Color fundus photograph: 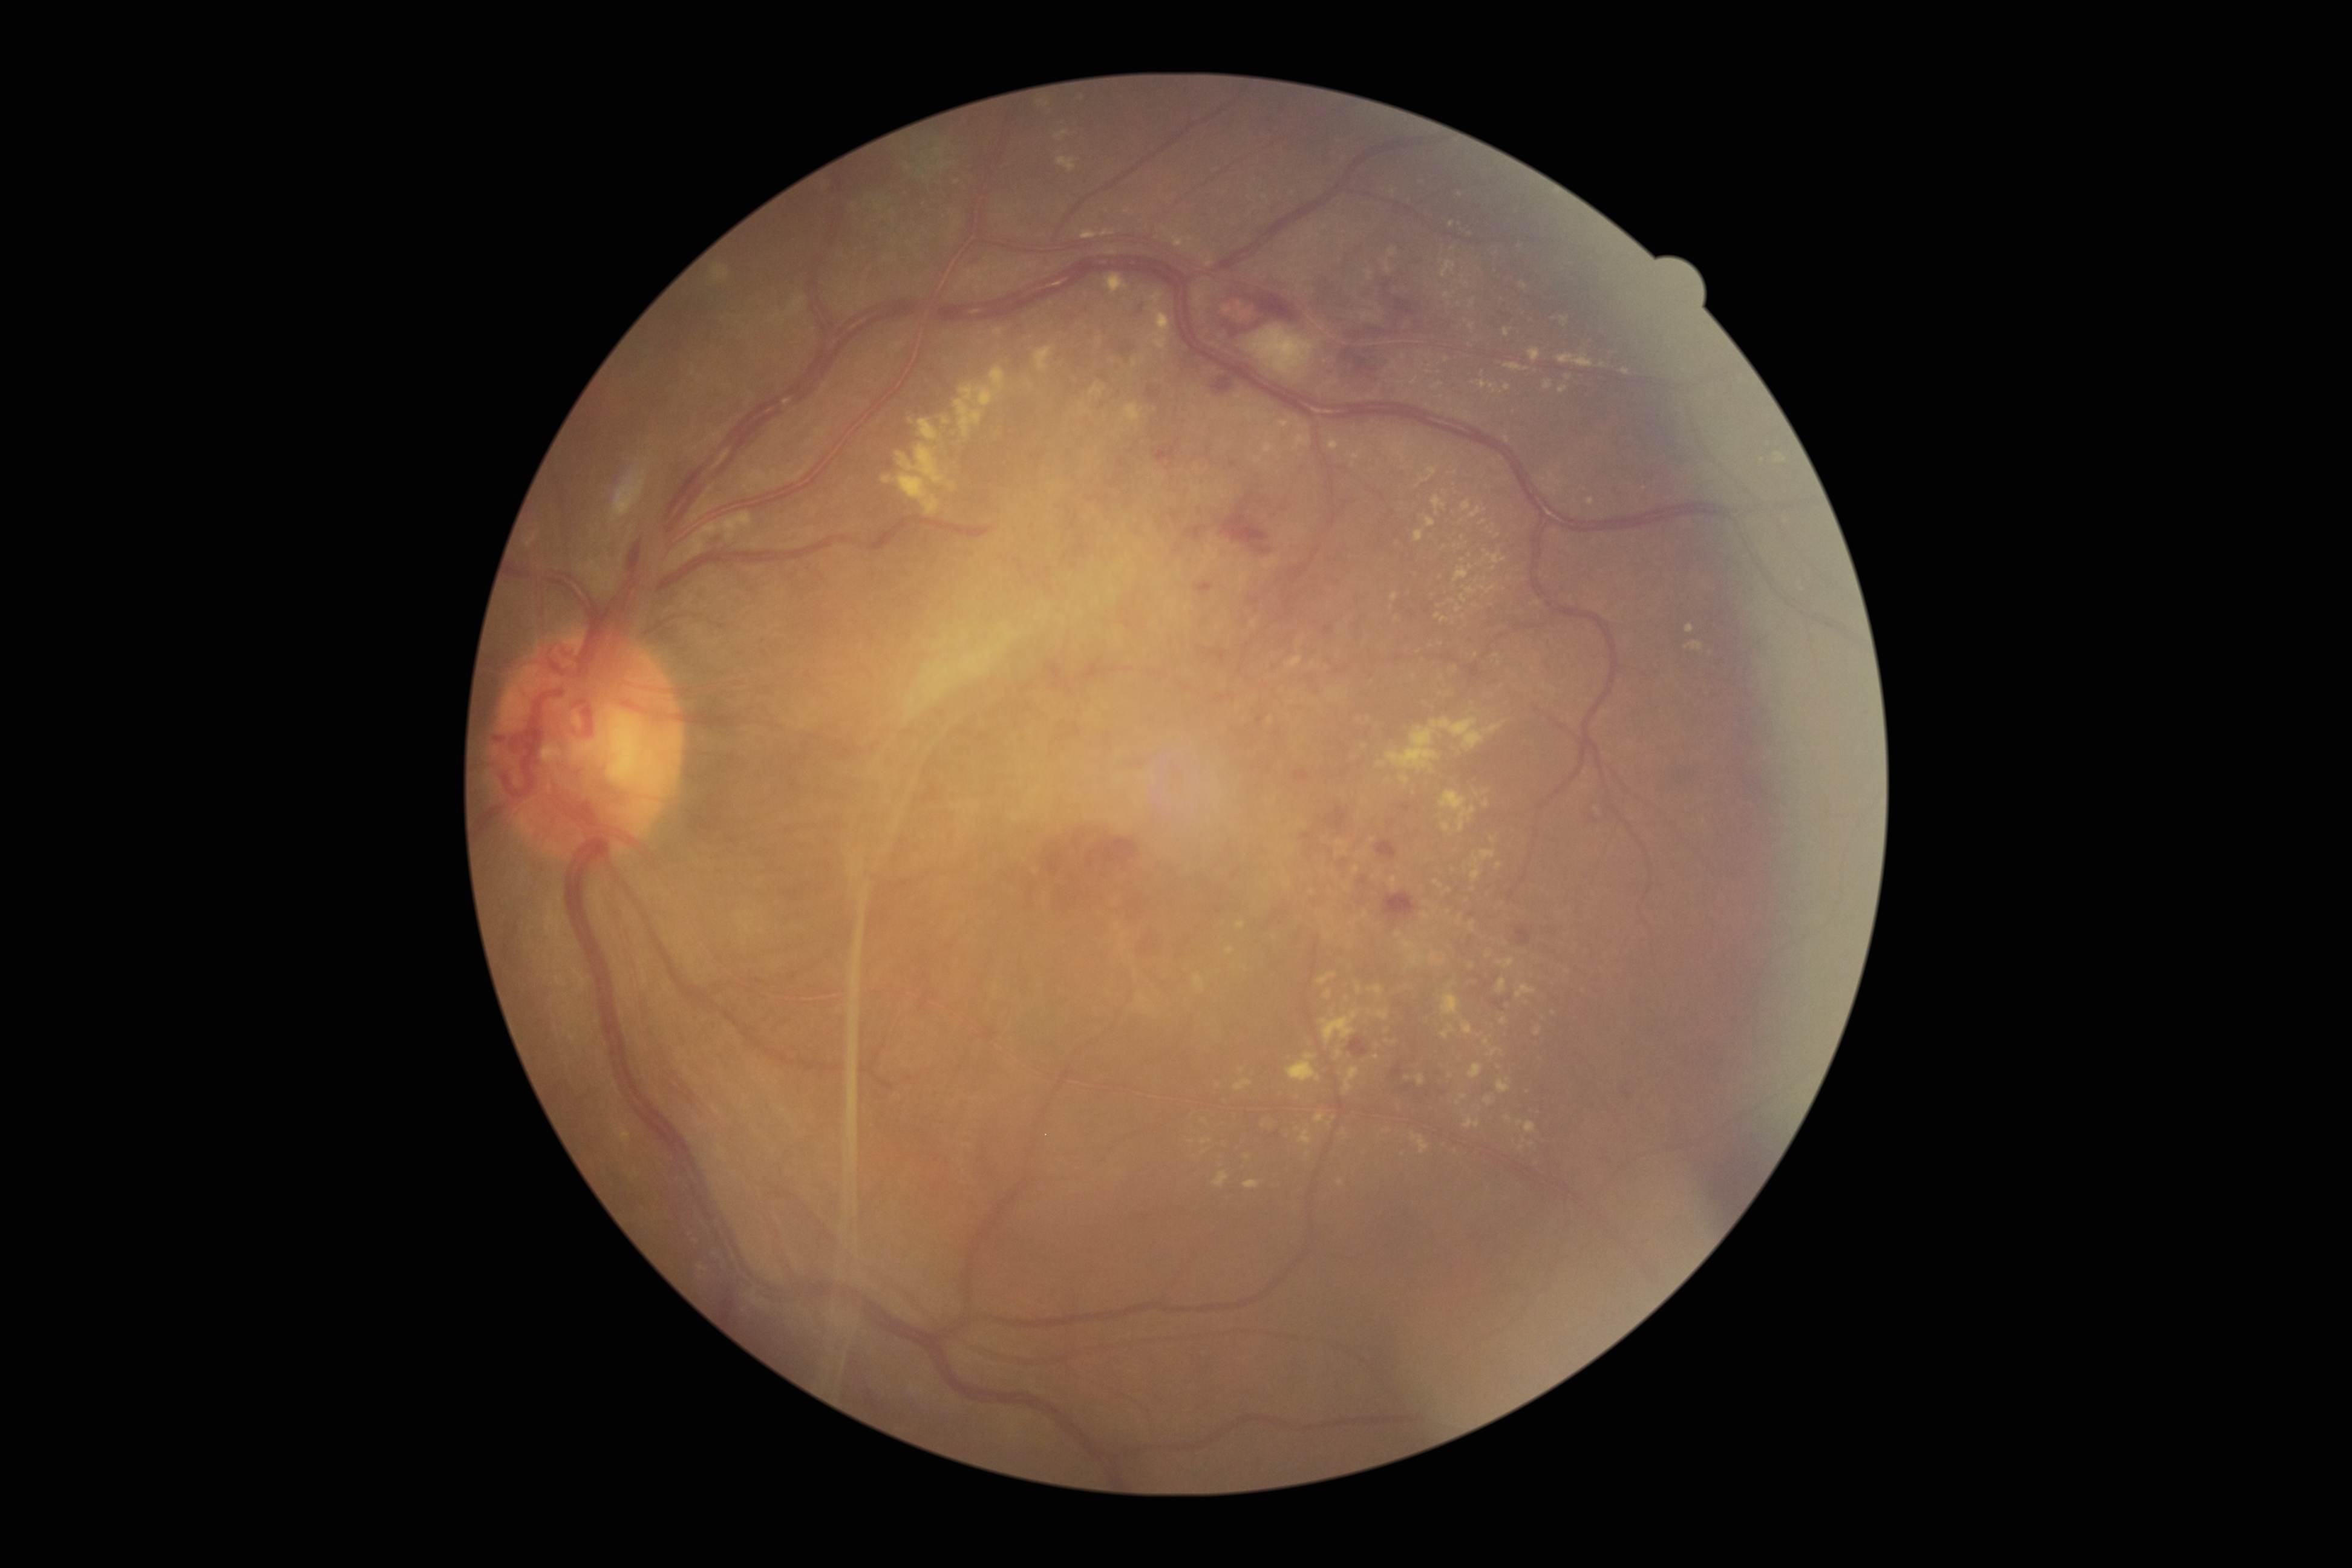
Diabetic retinopathy: PDR (grade 4) — neovascularization and/or vitreous/pre-retinal hemorrhage; proliferative diabetic retinopathy. Hard exudates are present, including at <region>1622, 368, 1630, 376</region> | <region>1481, 585, 1497, 593</region> | <region>1123, 403, 1144, 423</region> | <region>1089, 384, 1106, 396</region> | <region>1422, 913, 1431, 919</region> | <region>1429, 953, 1445, 964</region> | <region>1543, 379, 1553, 390</region> | <region>713, 267, 729, 283</region> | <region>1391, 593, 1399, 602</region> | <region>1484, 1097, 1494, 1105</region> | <region>1319, 1010, 1359, 1045</region>. Additional small hard exudates near x=911 y=421 | x=1396 y=619 | x=1308 y=1154 | x=1463 y=1096 | x=1496 y=656 | x=1205 y=1122 | x=1494 y=569 | x=1464 y=617 | x=1388 y=1042.